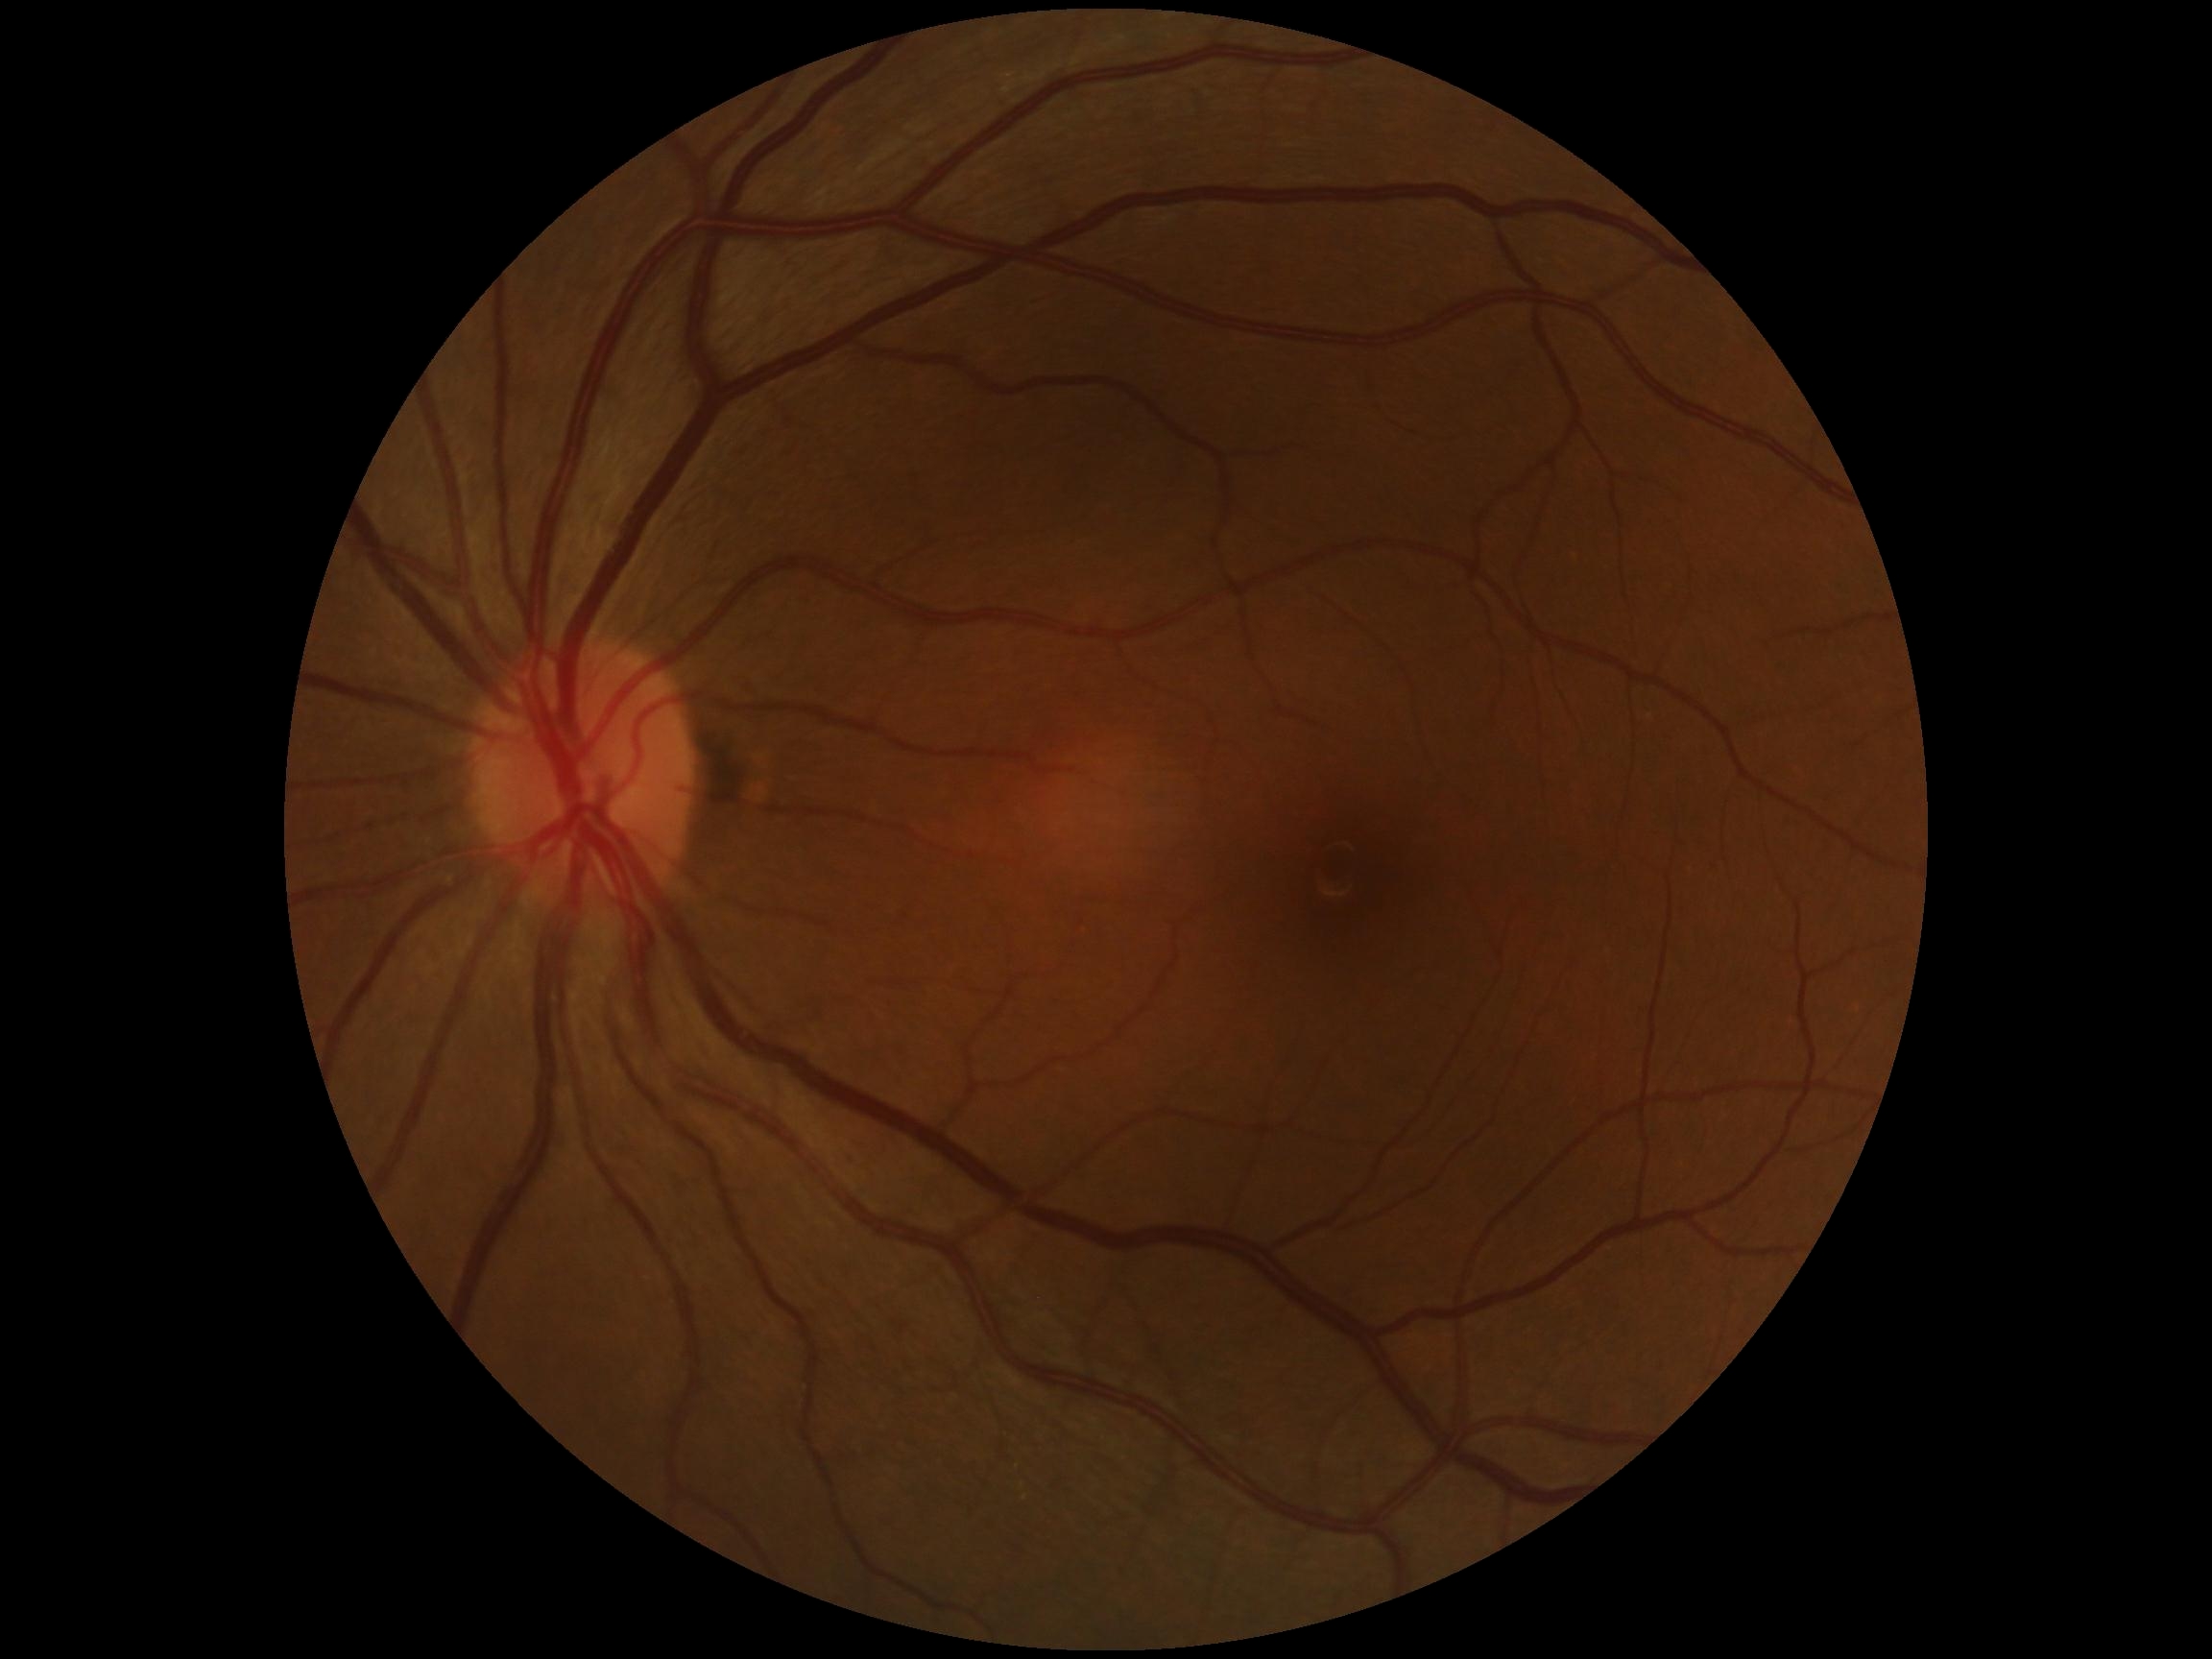
Diabetic retinopathy (DR): grade 0 (no apparent retinopathy) — no visible signs of diabetic retinopathy.